Color fundus photograph · centered on the optic disc · gender: M · autorefraction: -0.25 -1.75 x 175 · axial length (AL): 24.36 mm · corneal thickness: 622 µm · 52 years old · visual field mean defect: -0.79 dB · 30° field of view · intraocular pressure (IOP) (applanation tonometry): 19 mmHg · undilated pupil.
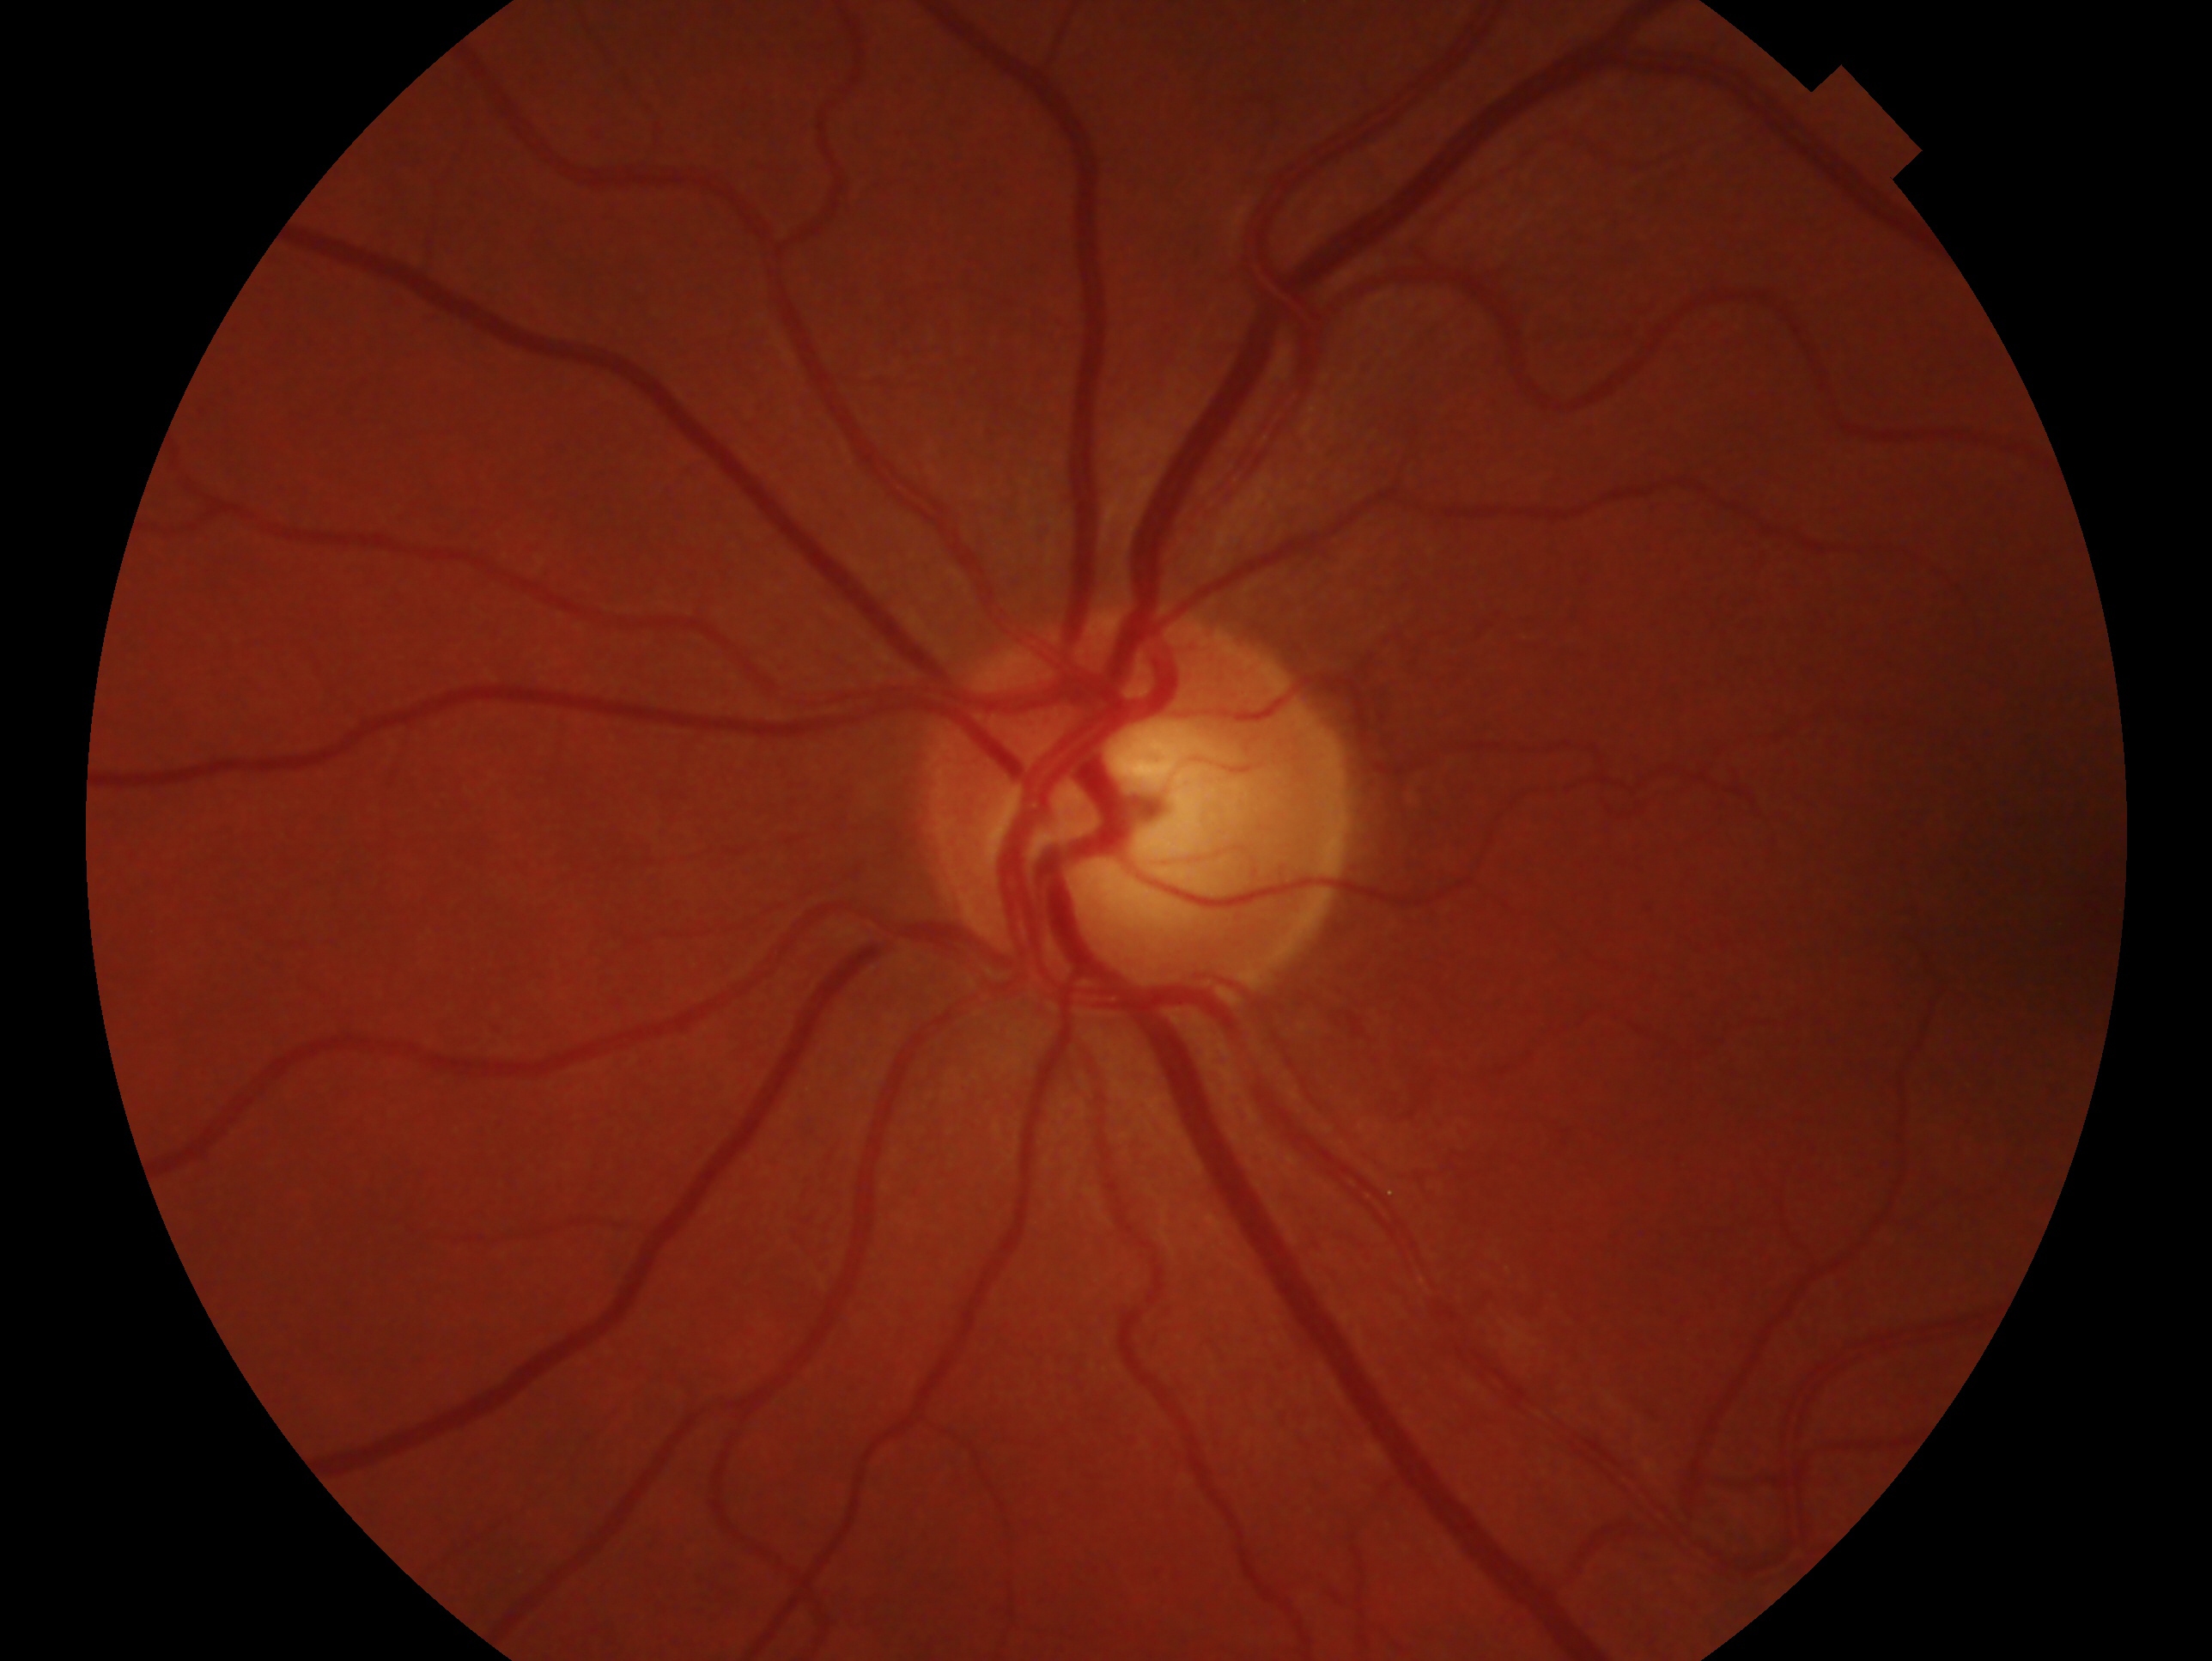
This is the left eye. Assessment: glaucoma cannot be excluded.